Infant wide-field retinal image:
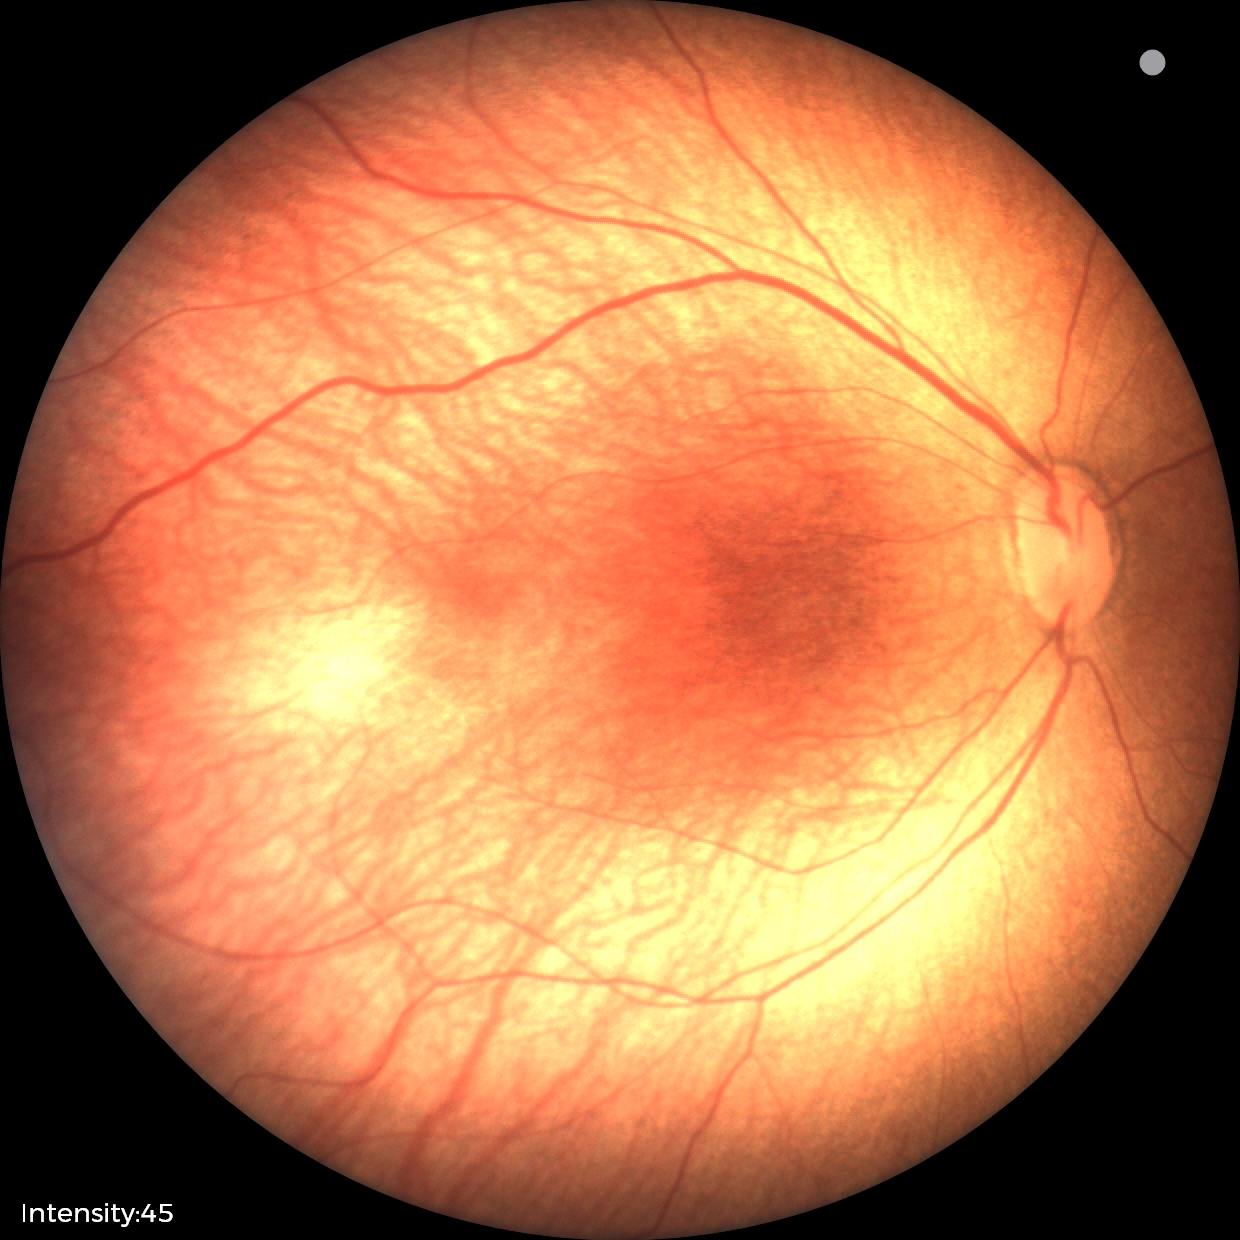 Screening: ROP stage 1.